Color fundus image; 45° FOV; 1380x1382px
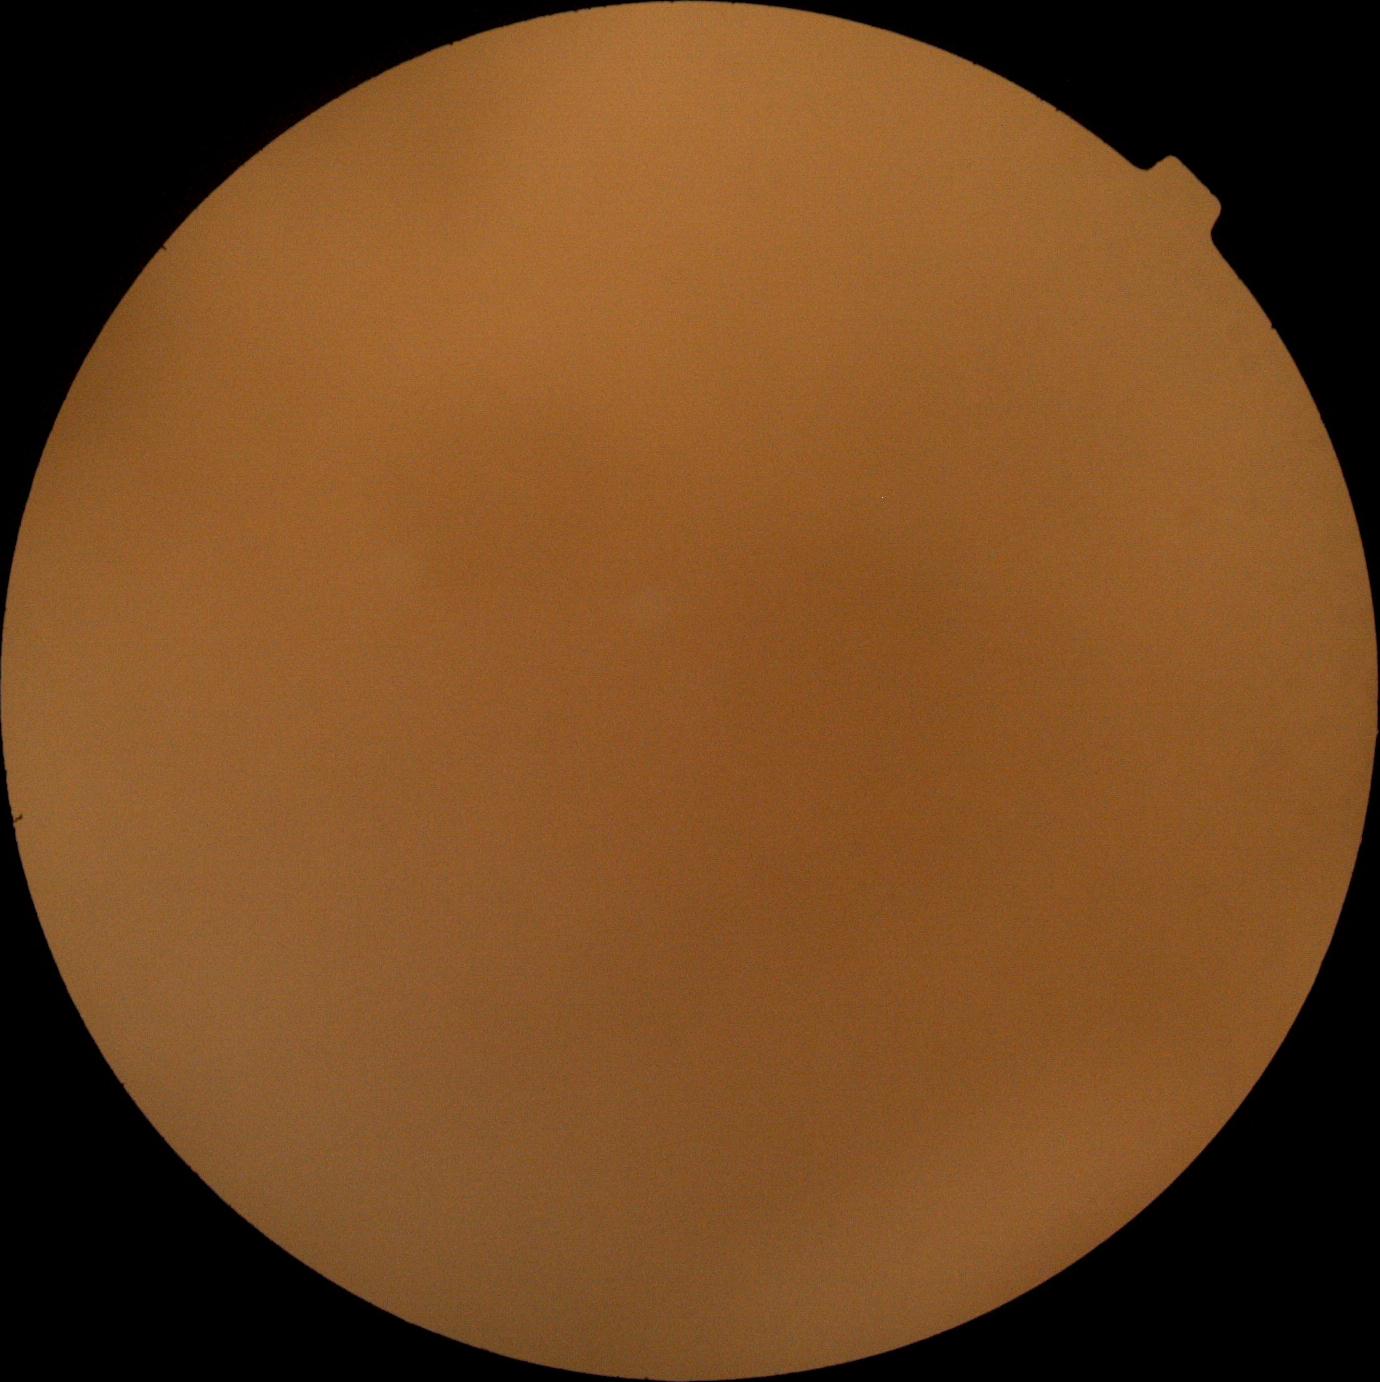 DR severity: ungradable due to poor image quality. Ungradable image — DR severity cannot be determined.